Wide-field contact fundus photograph of an infant
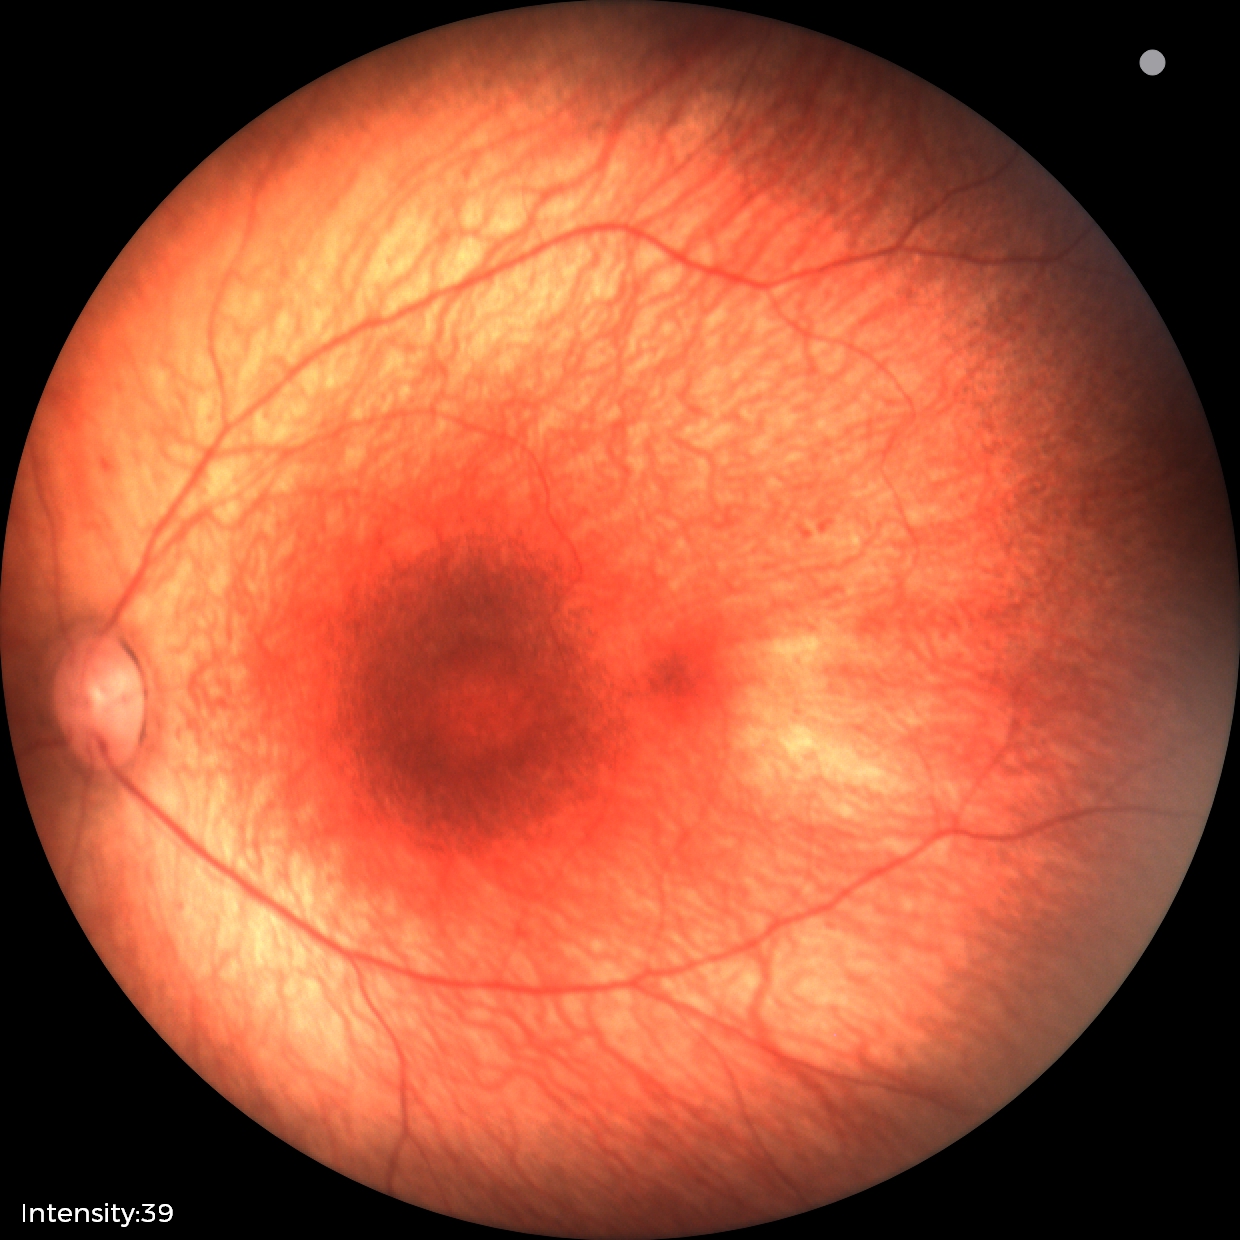

Screening diagnosis: normal retinal appearance.